Davis DR grading, 848 x 848 pixels, NIDEK AFC-230 fundus camera, without pupil dilation.
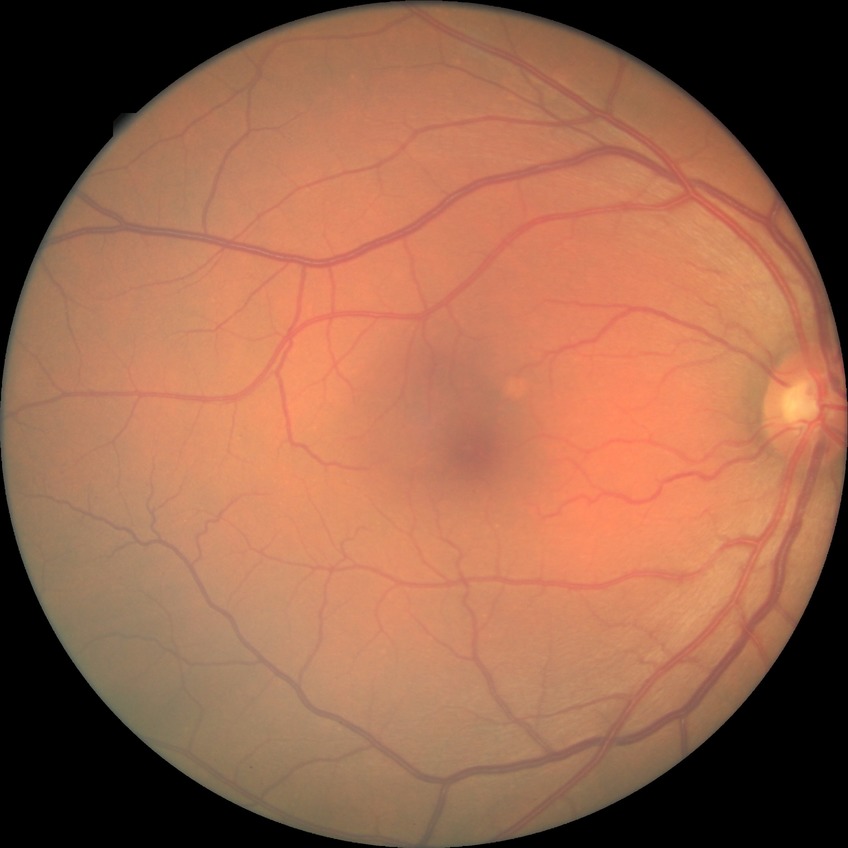 Davis grading is no diabetic retinopathy.